Wide-field fundus image from infant ROP screening: 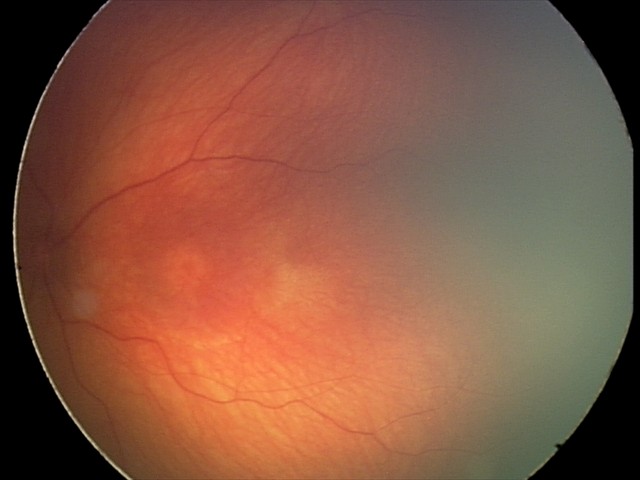

Screening examination consistent with optic nerve hypoplasia.